2228x1652px — 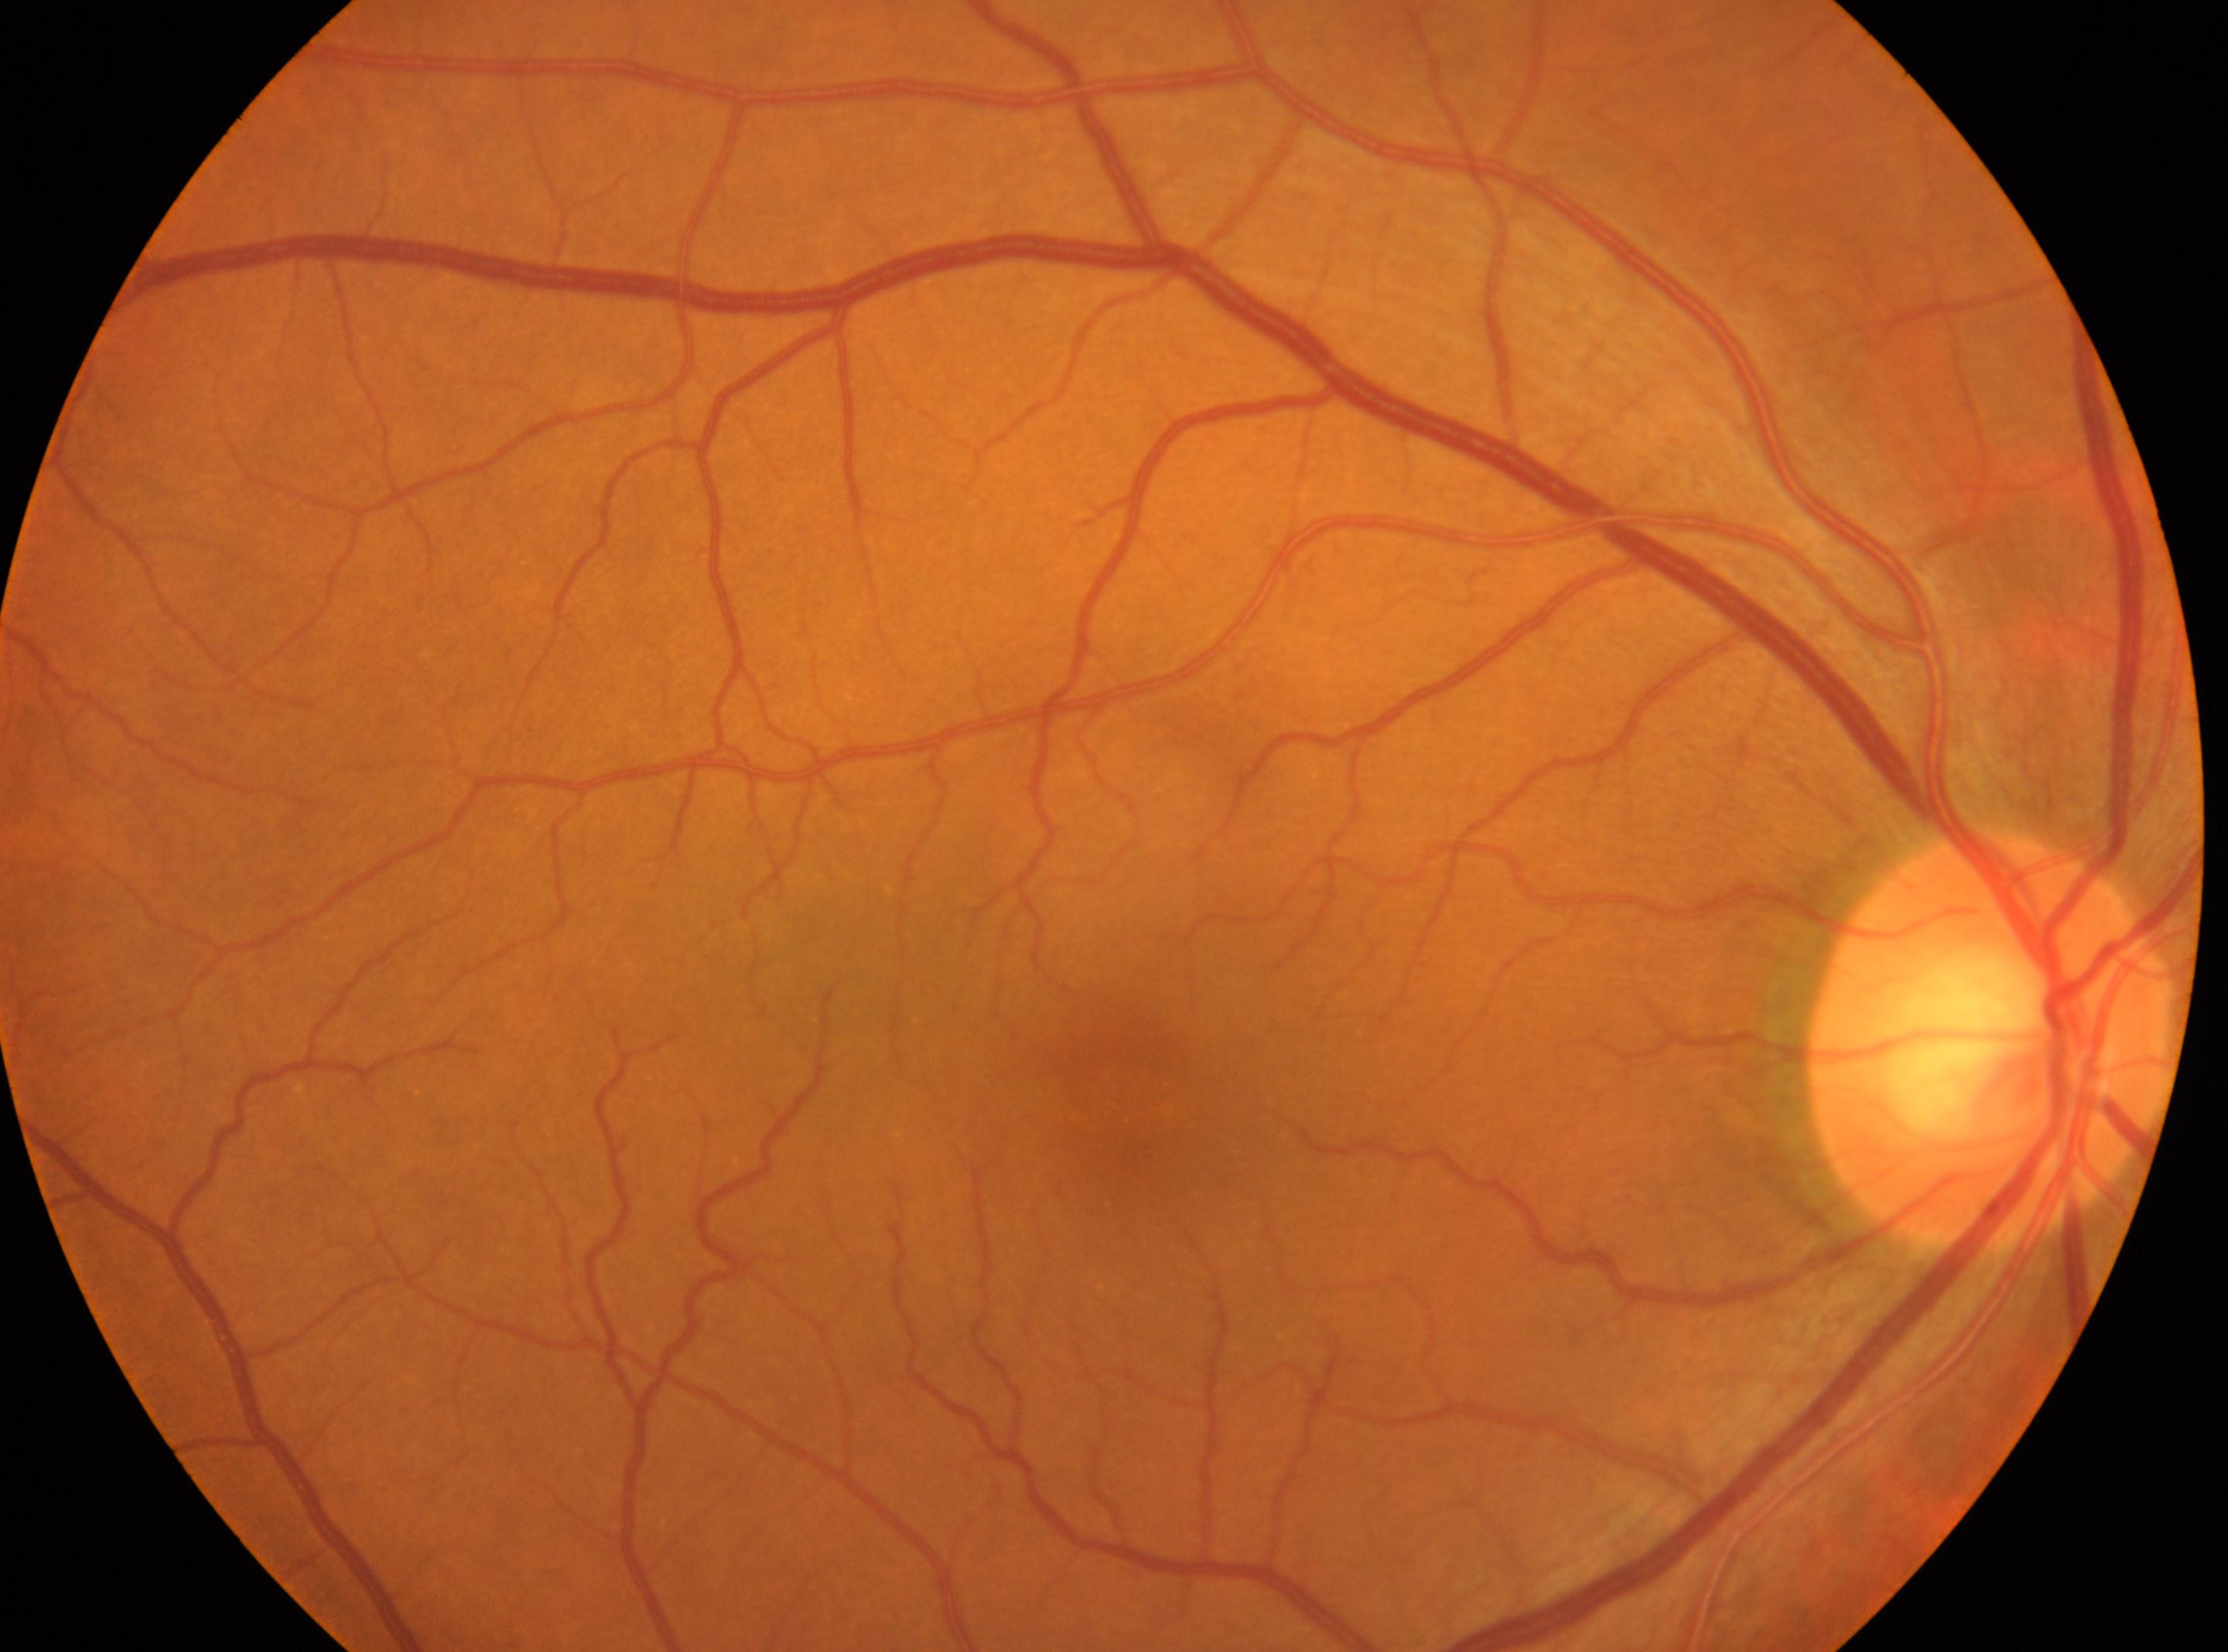
{"fovea": "1136px, 1100px", "dr_impression": "No apparent diabetic retinopathy", "dr_grade": "0 — no visible signs of diabetic retinopathy", "eye": "oculus dexter", "optic_disc": "1991px, 1038px"}